45-degree field of view · 2048x1536 — 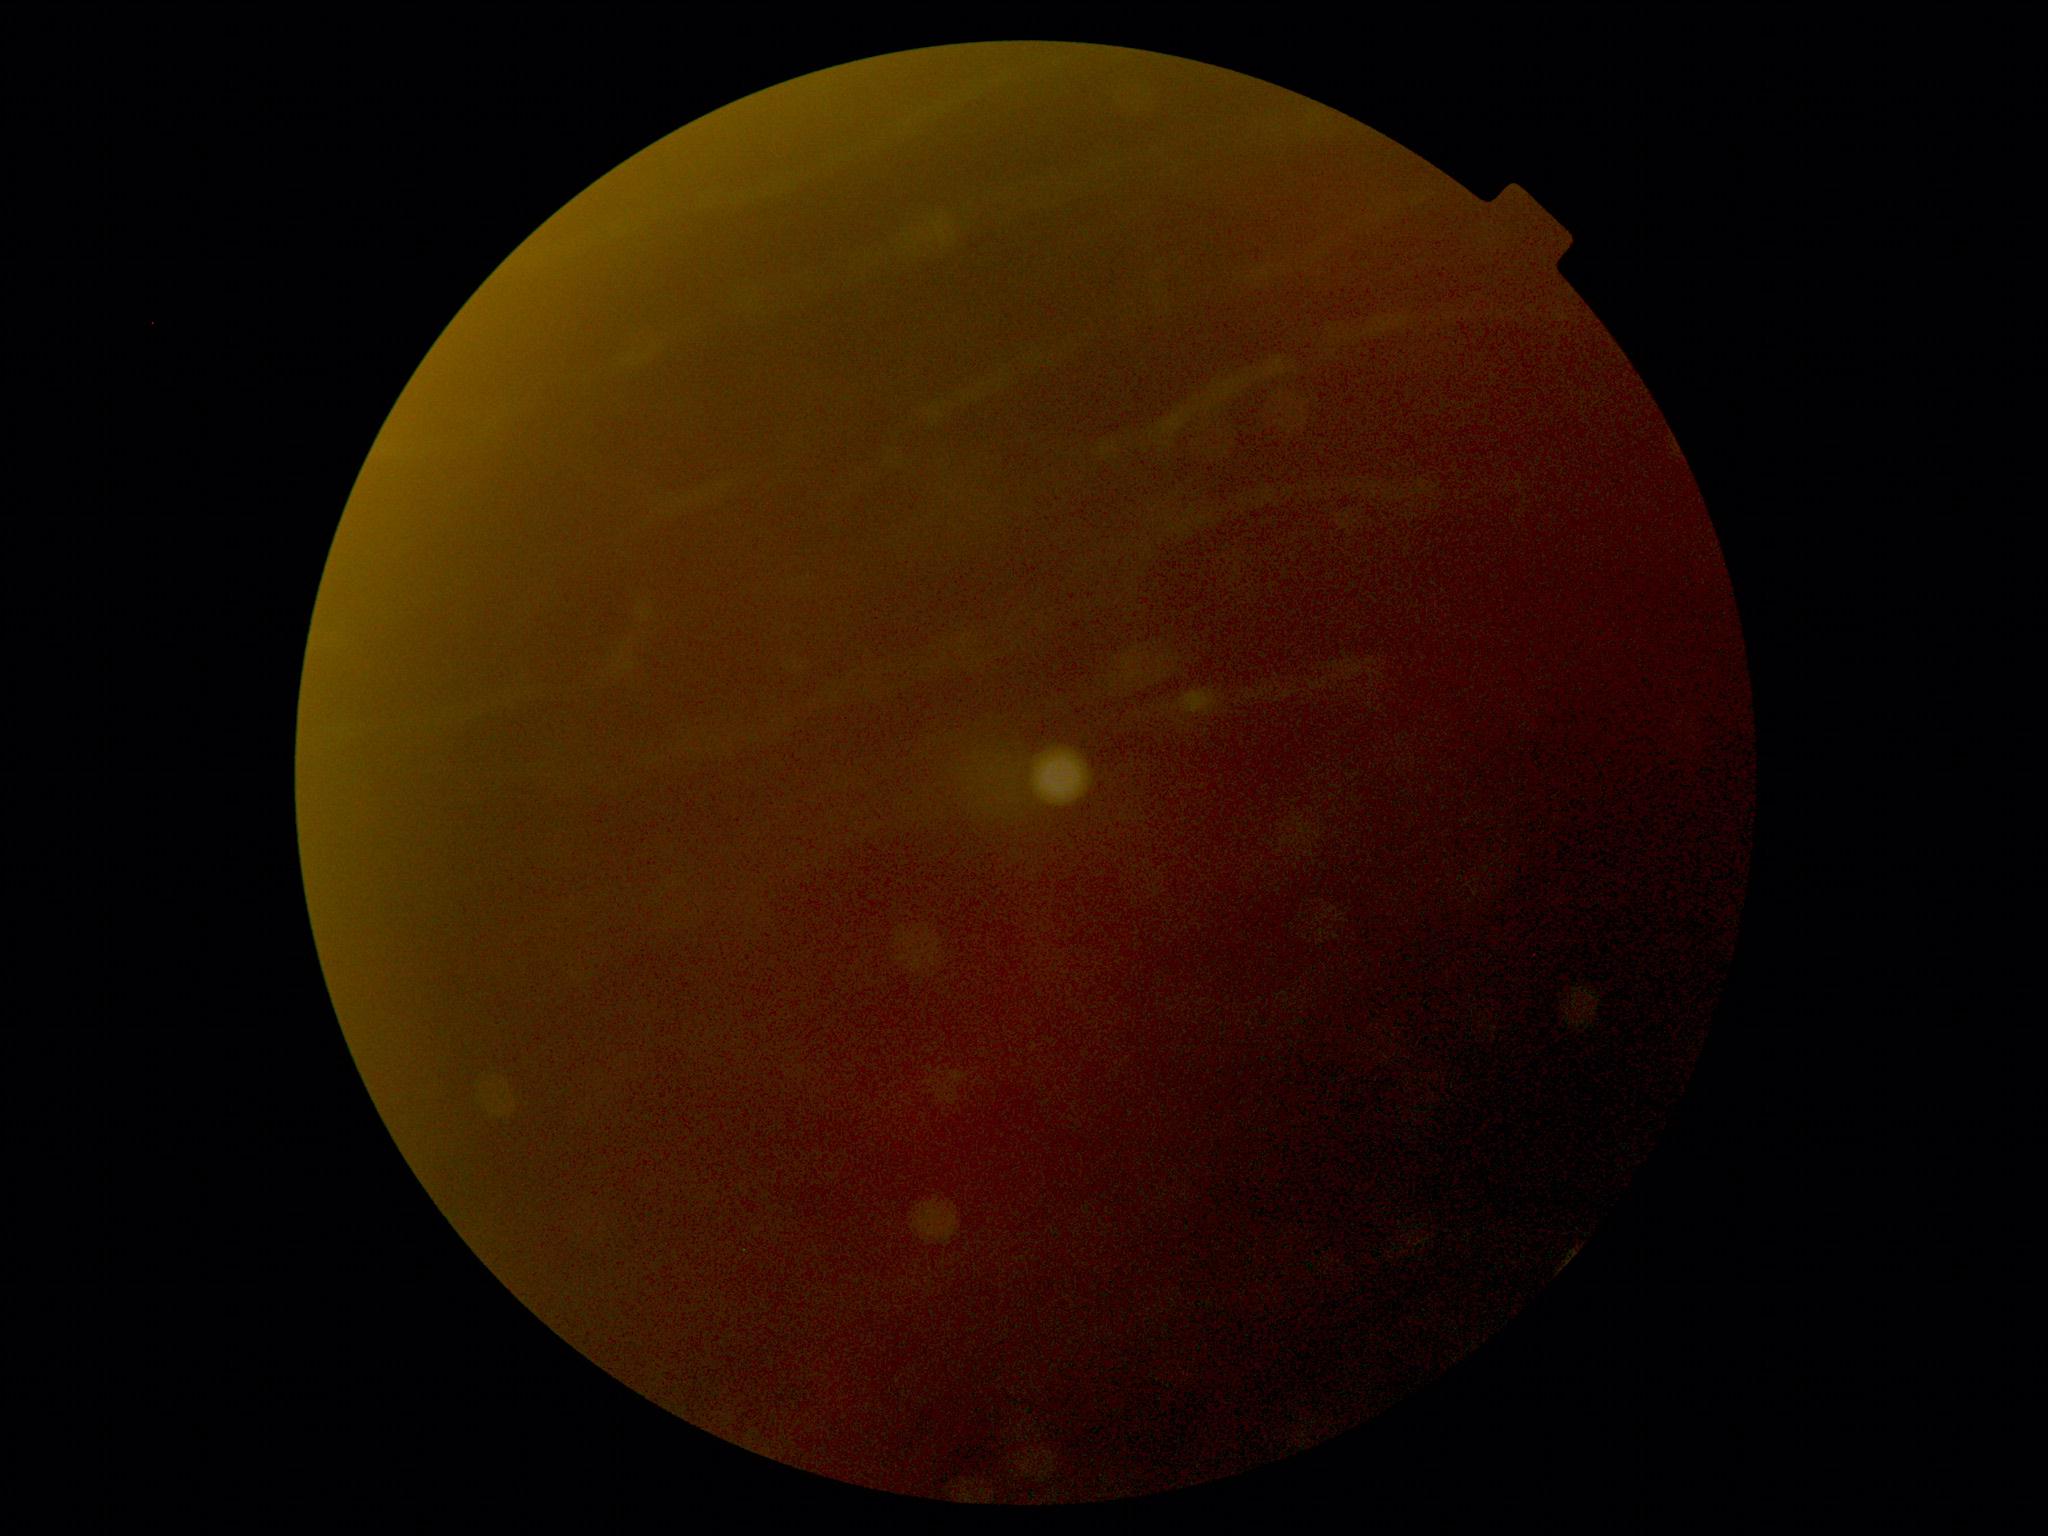
Quality too poor to assess for DR.
Diabetic retinopathy is ungradable due to poor image quality.